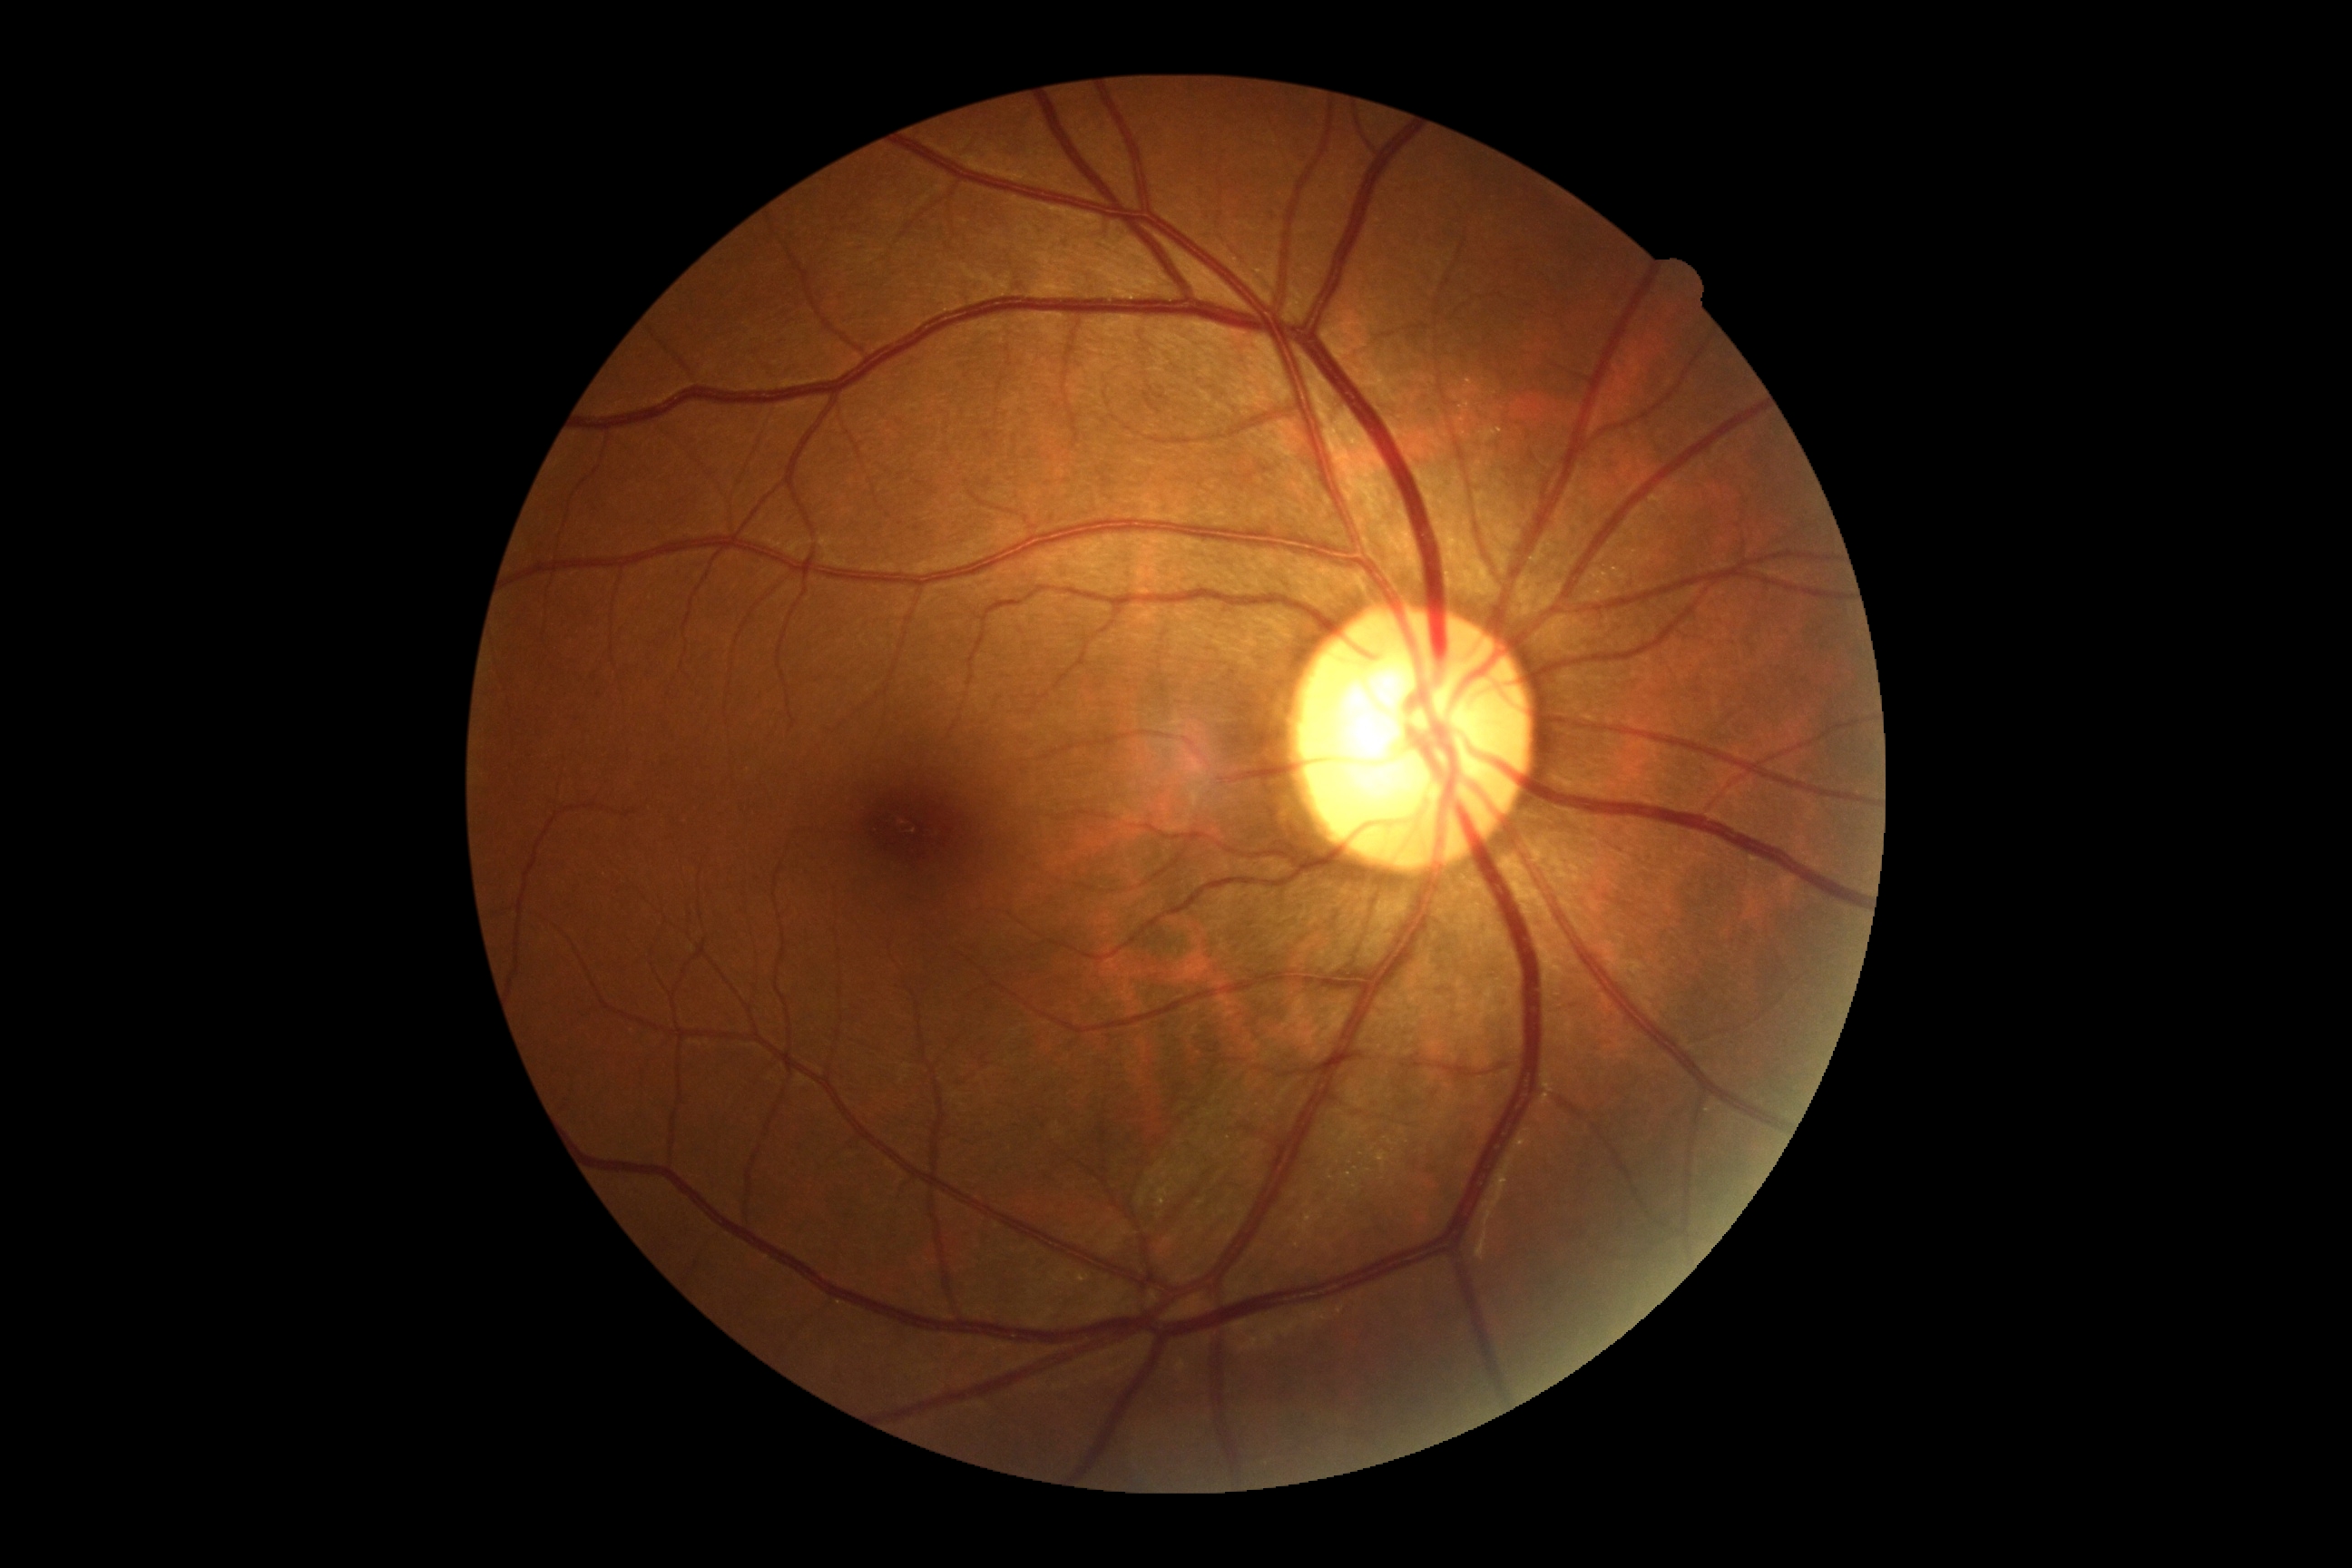

DR stage is 0/4.